1920x1440px · fundus photo · captured on a Bosch handheld camera.
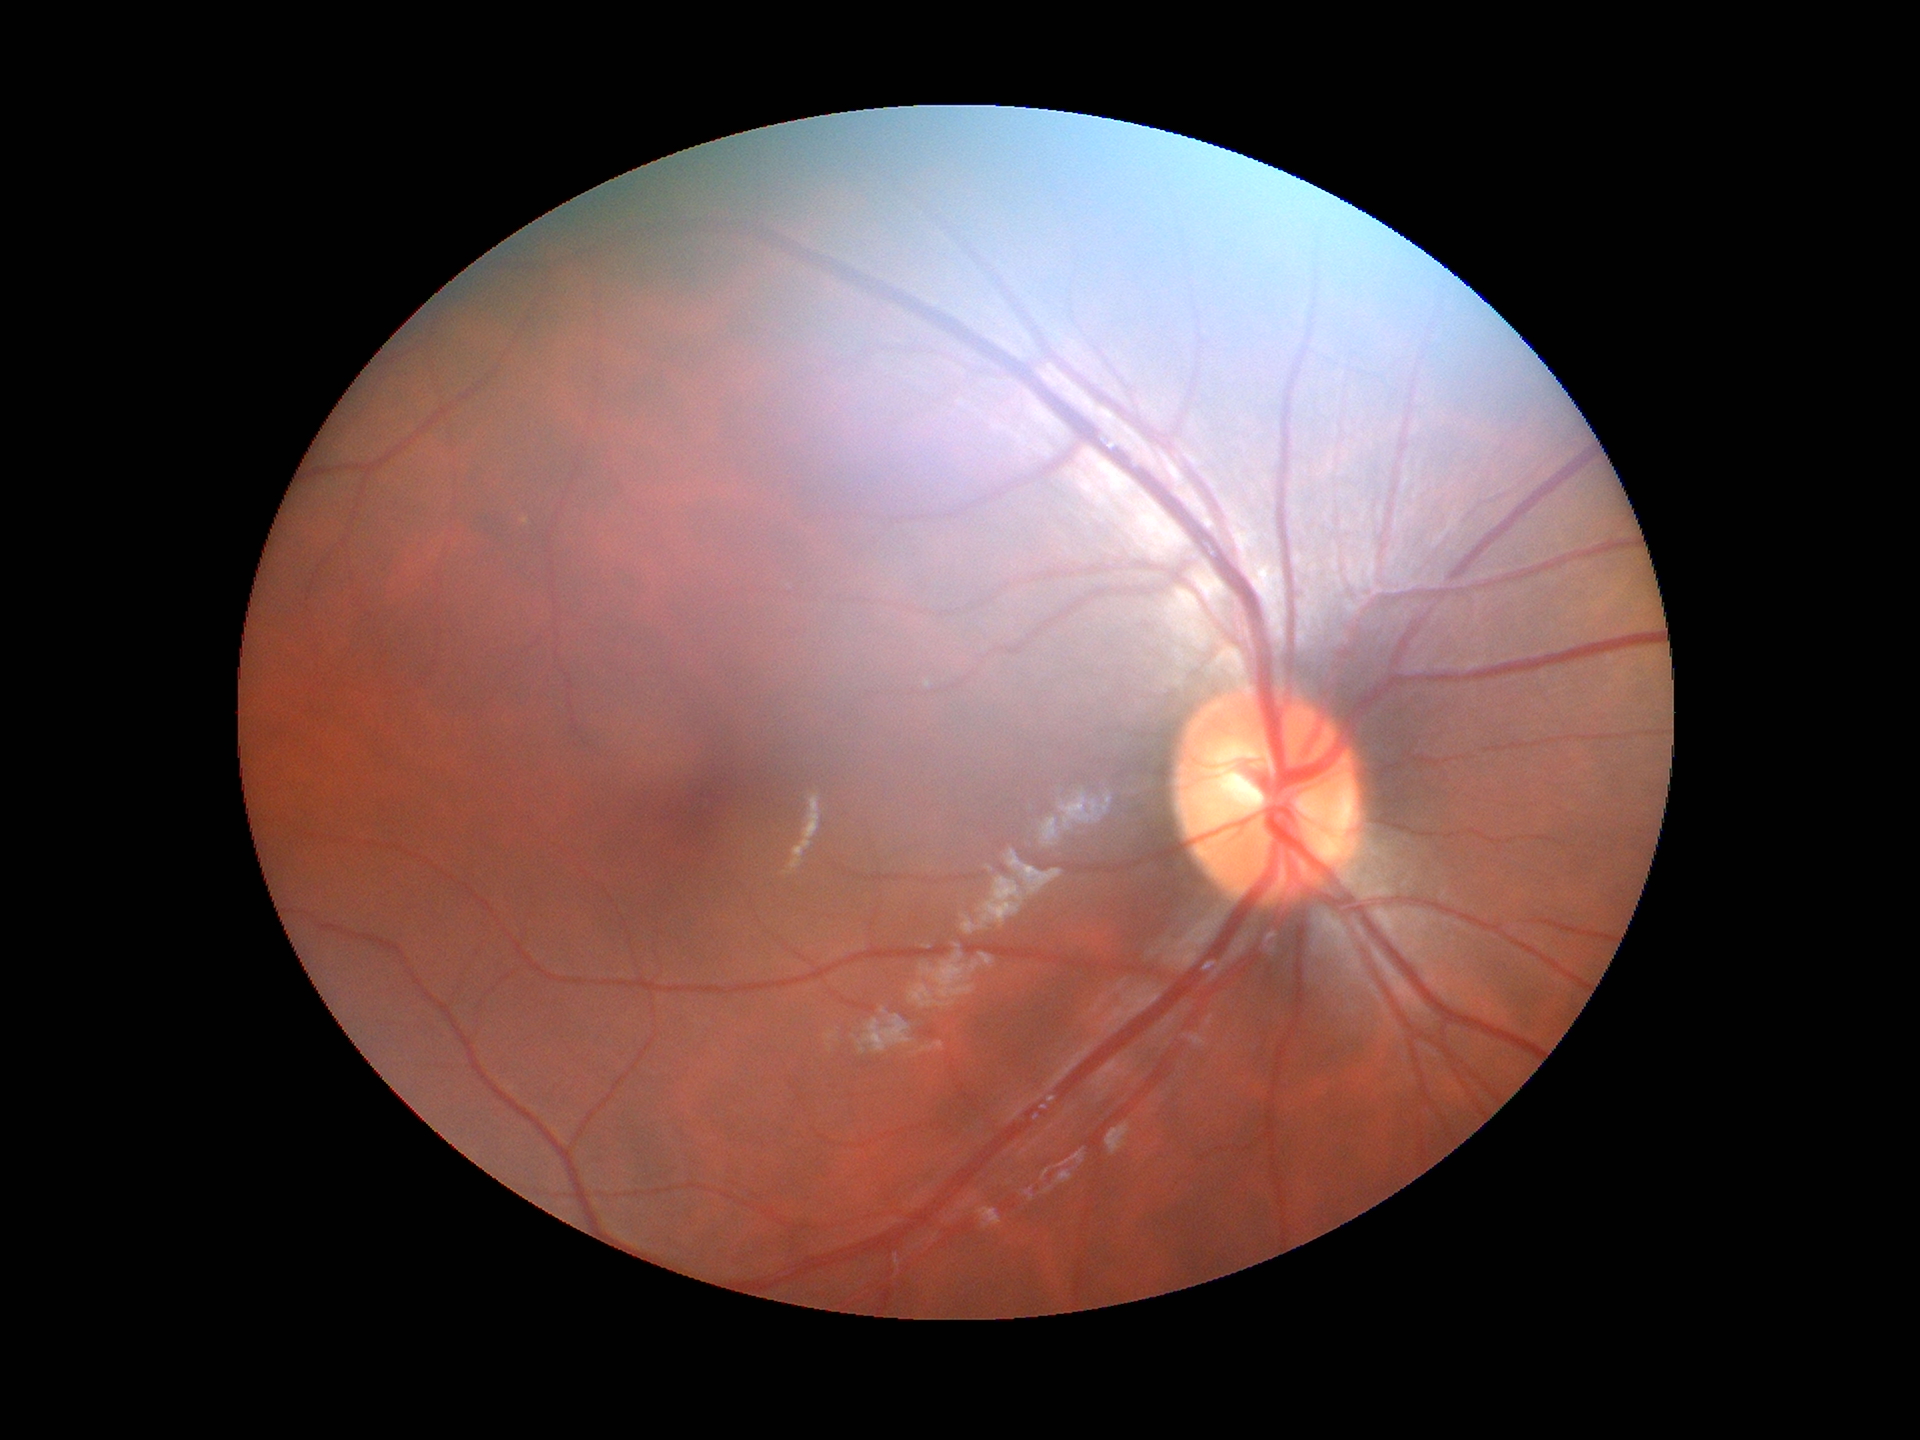
Vertical cup-disc ratio: 0.49.
Horizontal cup-disc ratio of 0.53.
Not suspicious for glaucoma (1/5 graders called glaucoma suspect).